45° field of view.
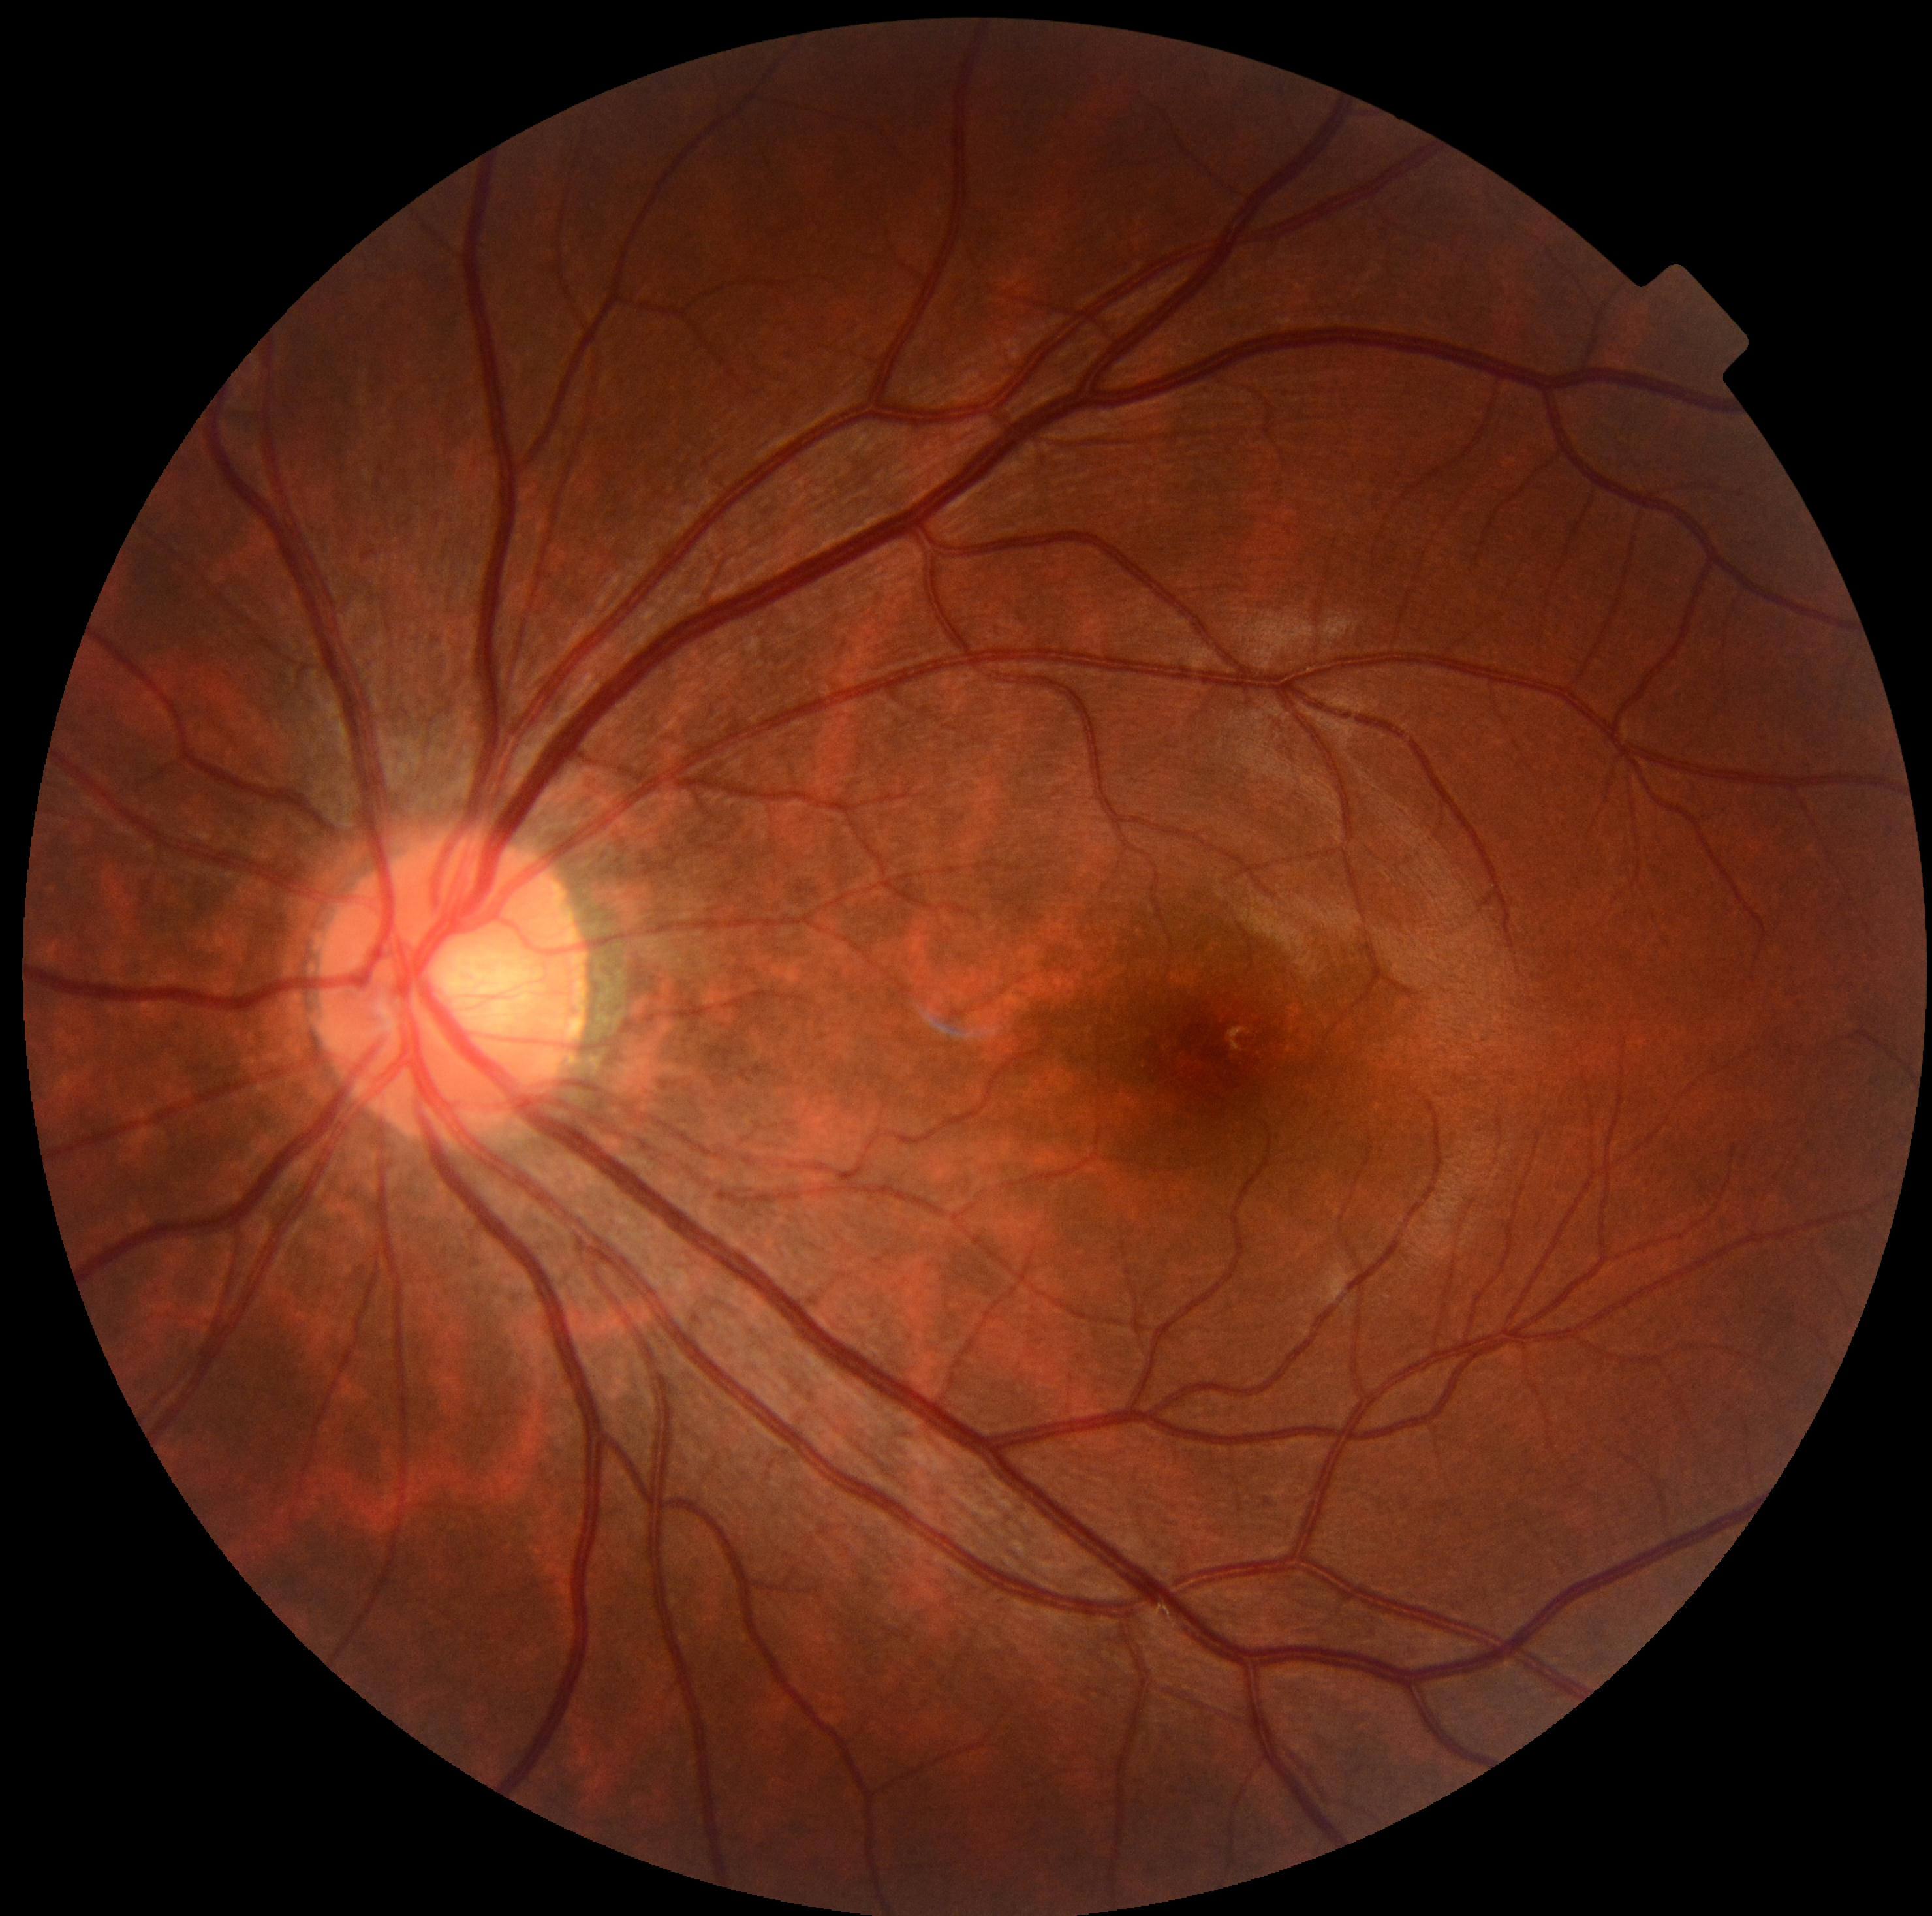
Retinopathy grade is 0.